Wide-field fundus photograph of an infant: 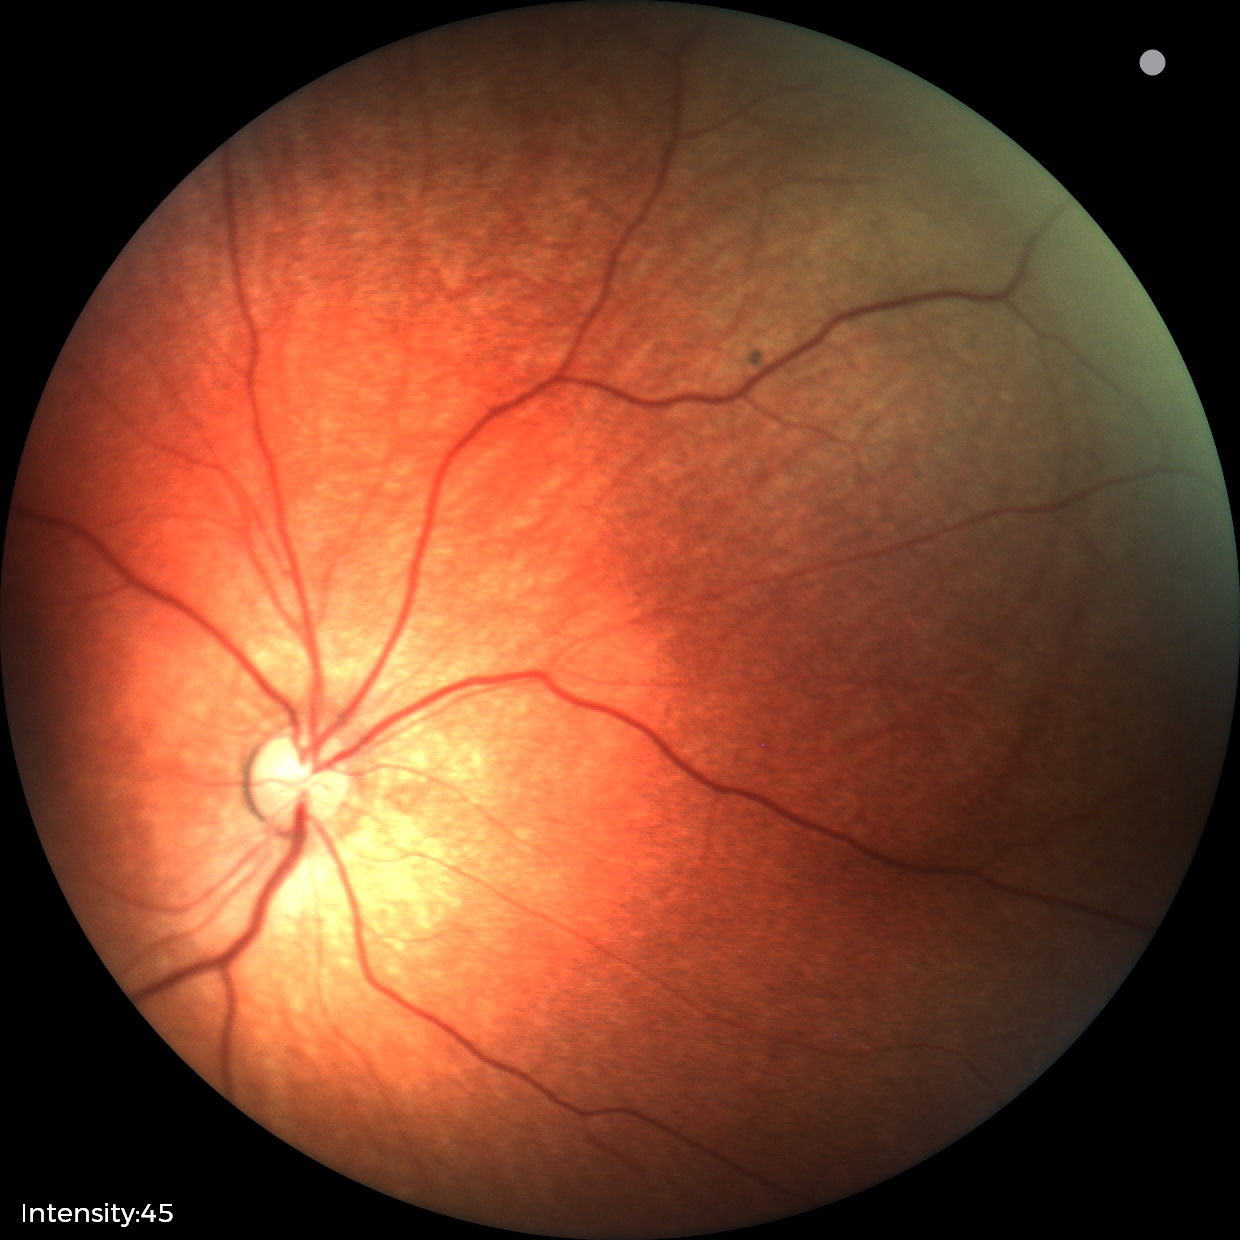
Physiological retinal appearance for postconceptual age.